Color fundus image · image size 2352x1568.
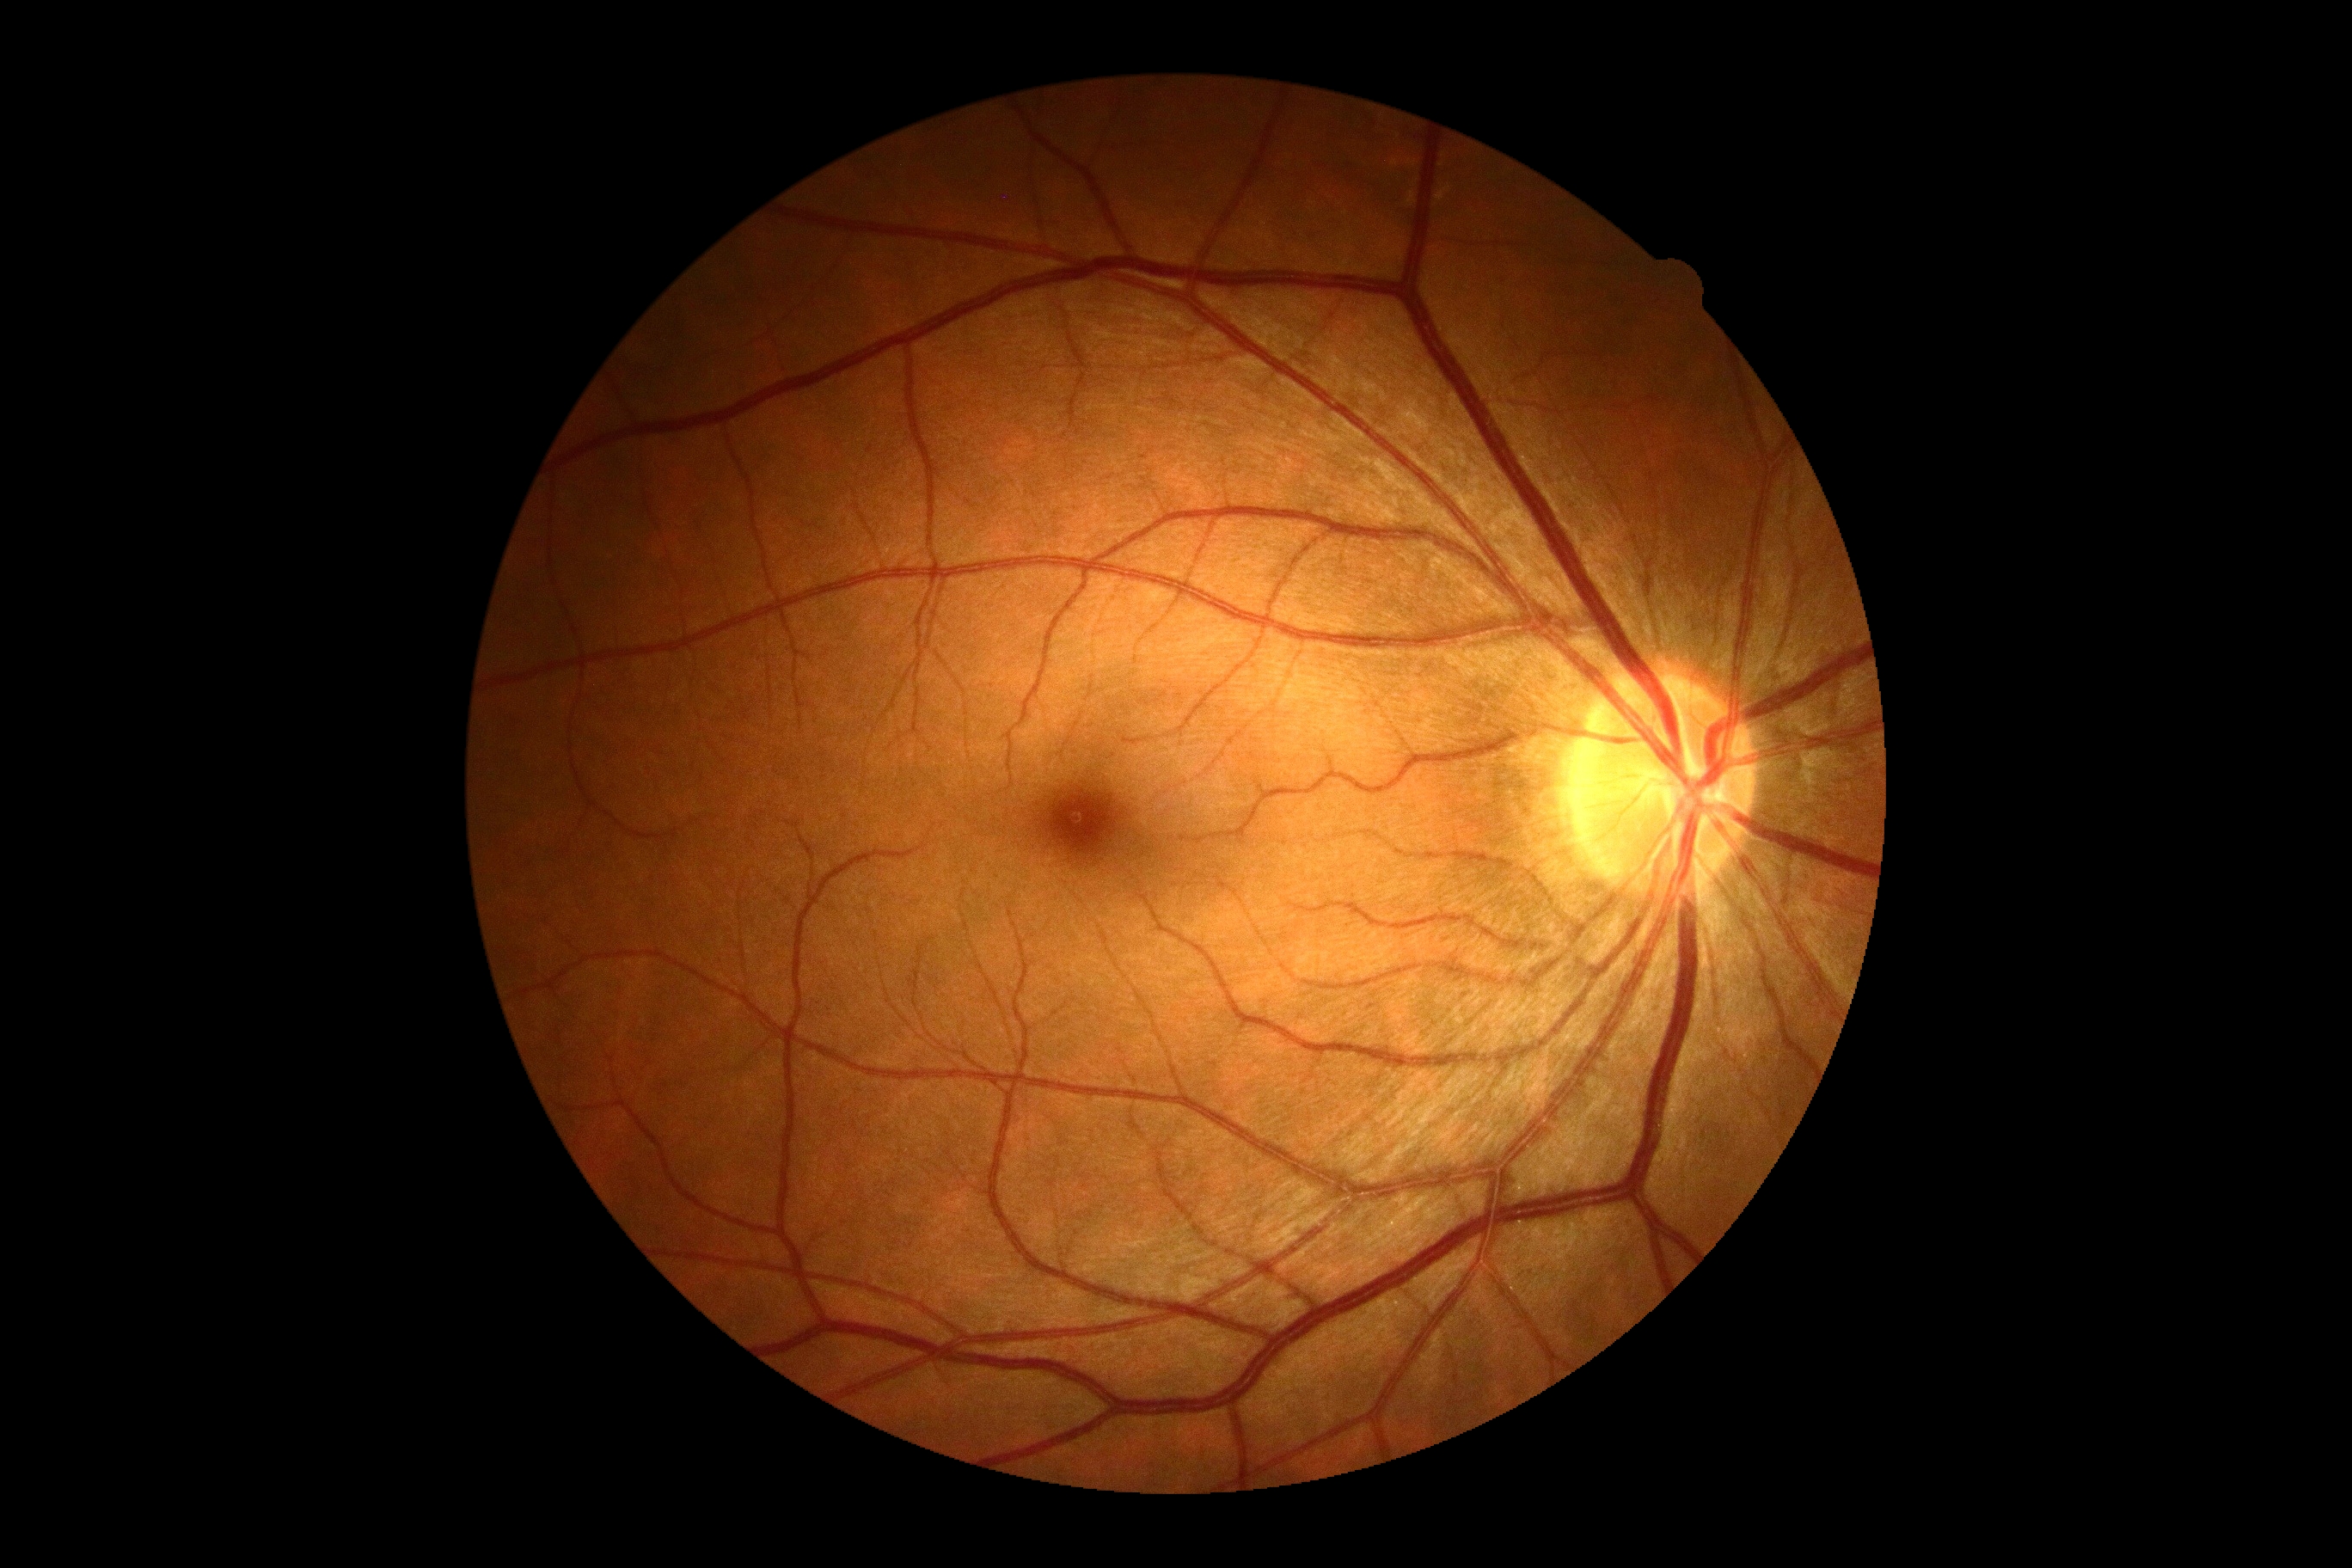 Diabetic retinopathy is 0/4.